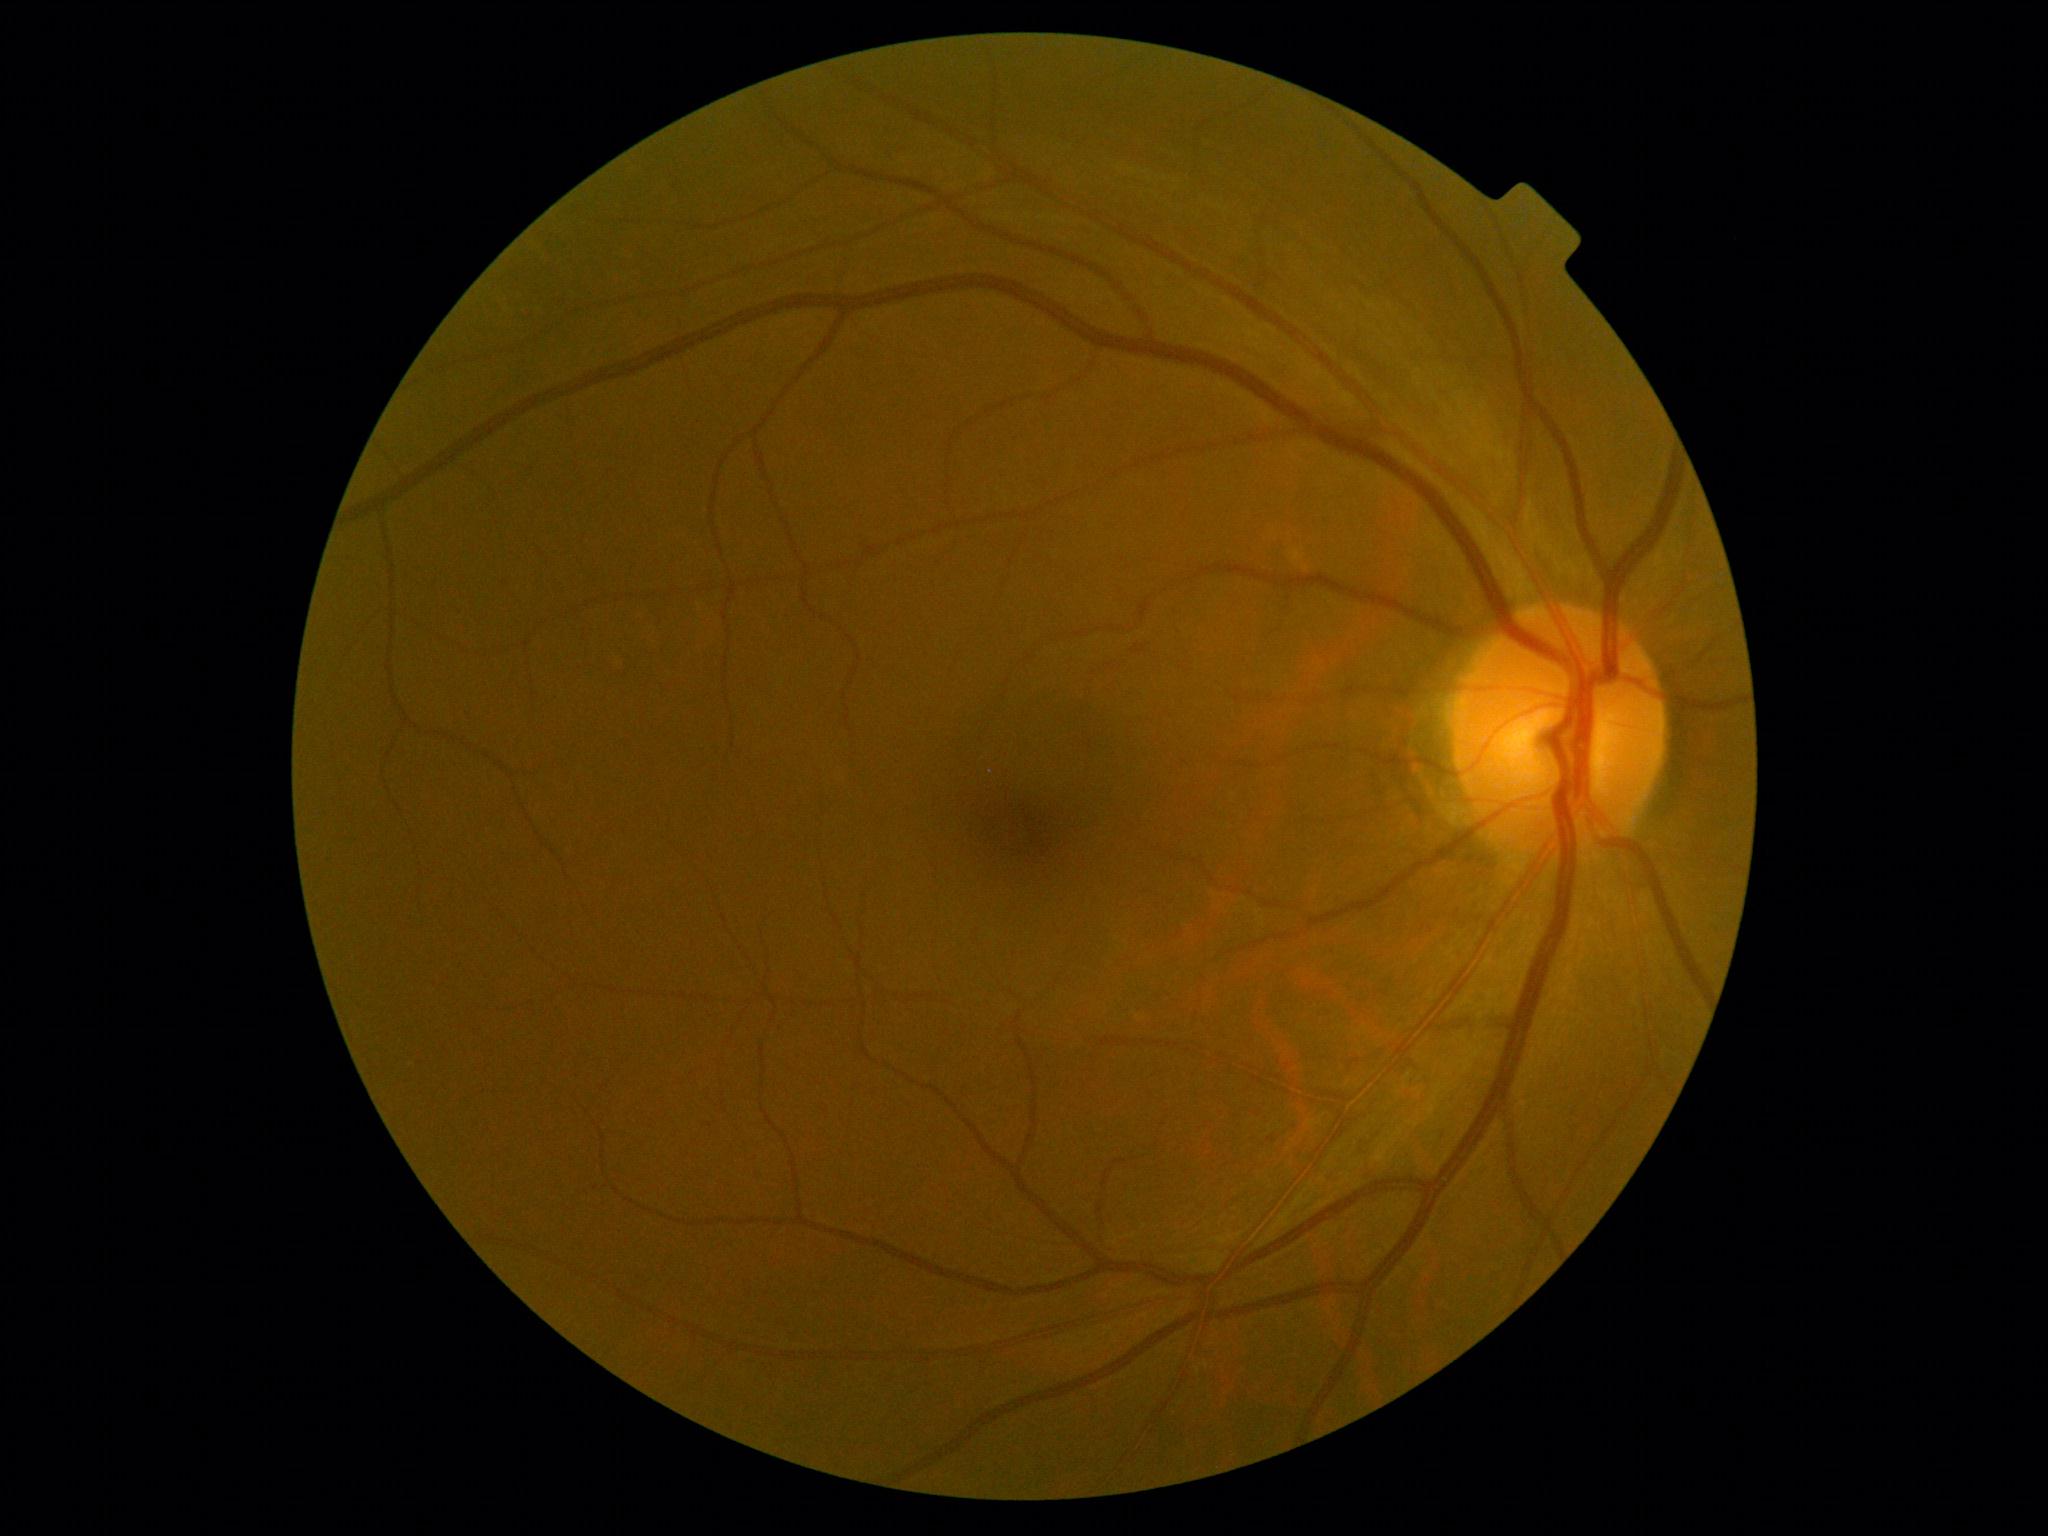

{"dr_grade": "0"}